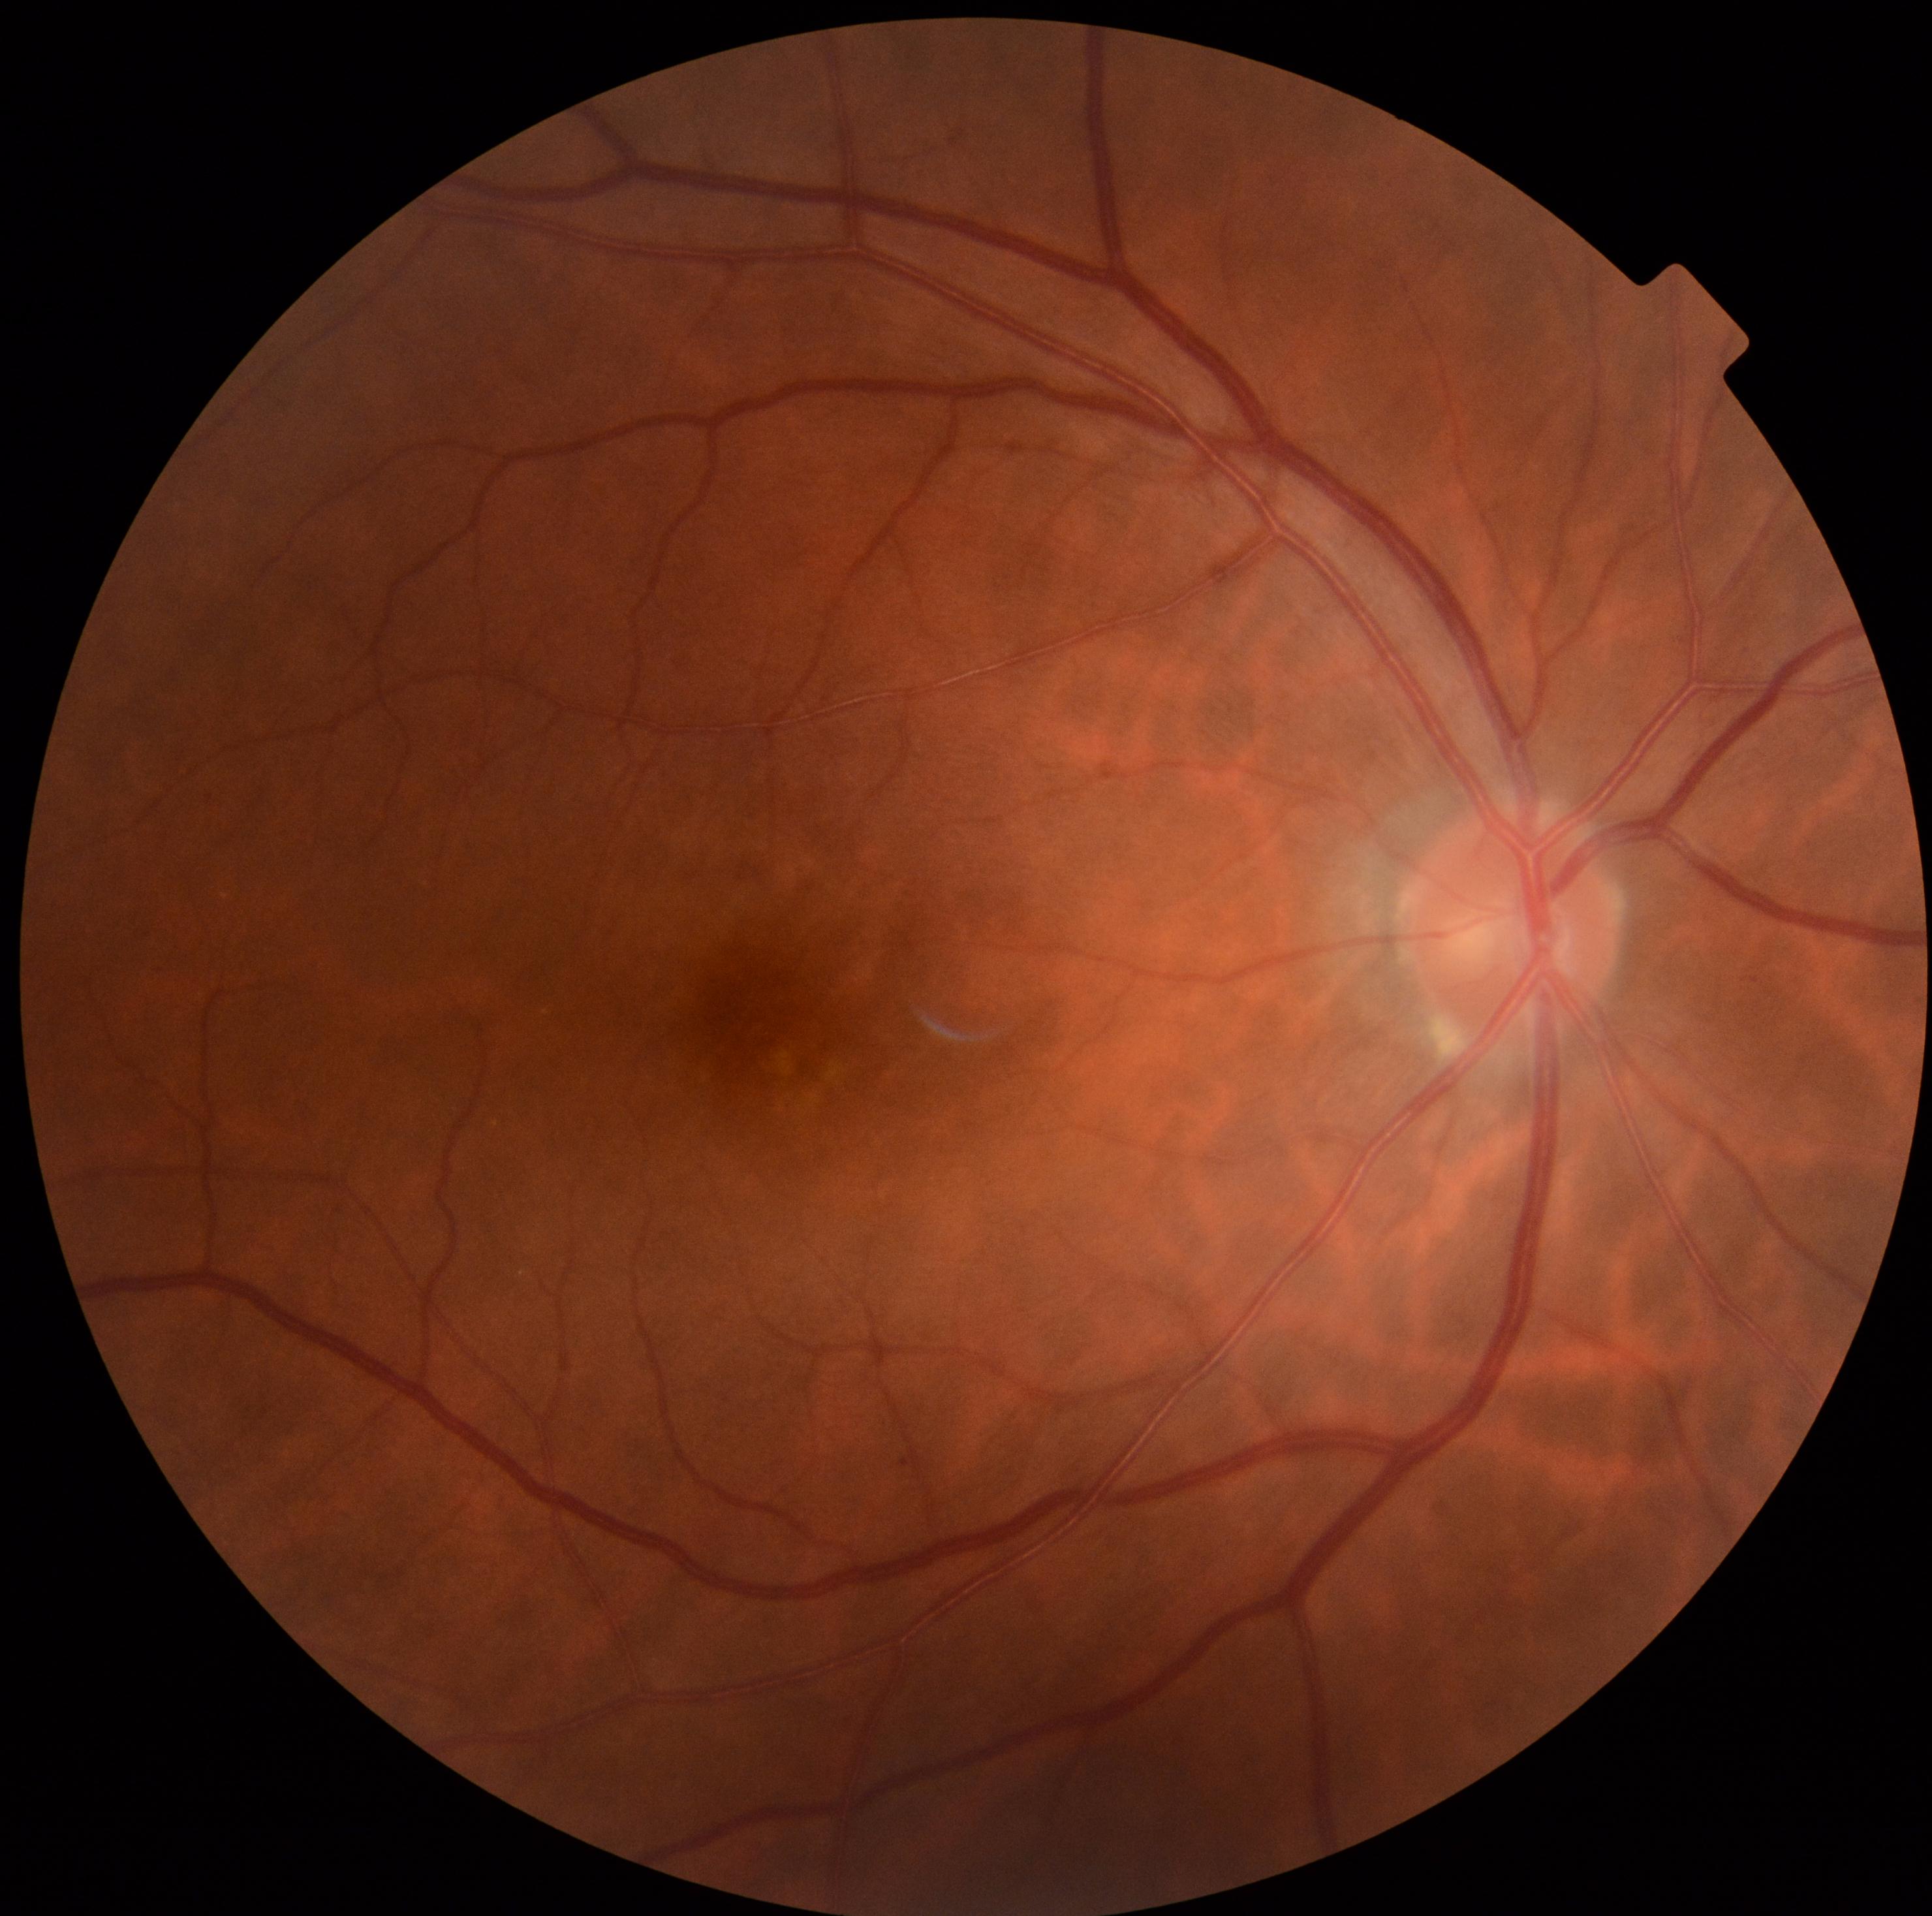
Findings:
• diabetic retinopathy grade — no apparent retinopathy (0) — no visible signs of diabetic retinopathy
• DR impression — negative for DR